1932x1932px, 45-degree field of view, fundus photo
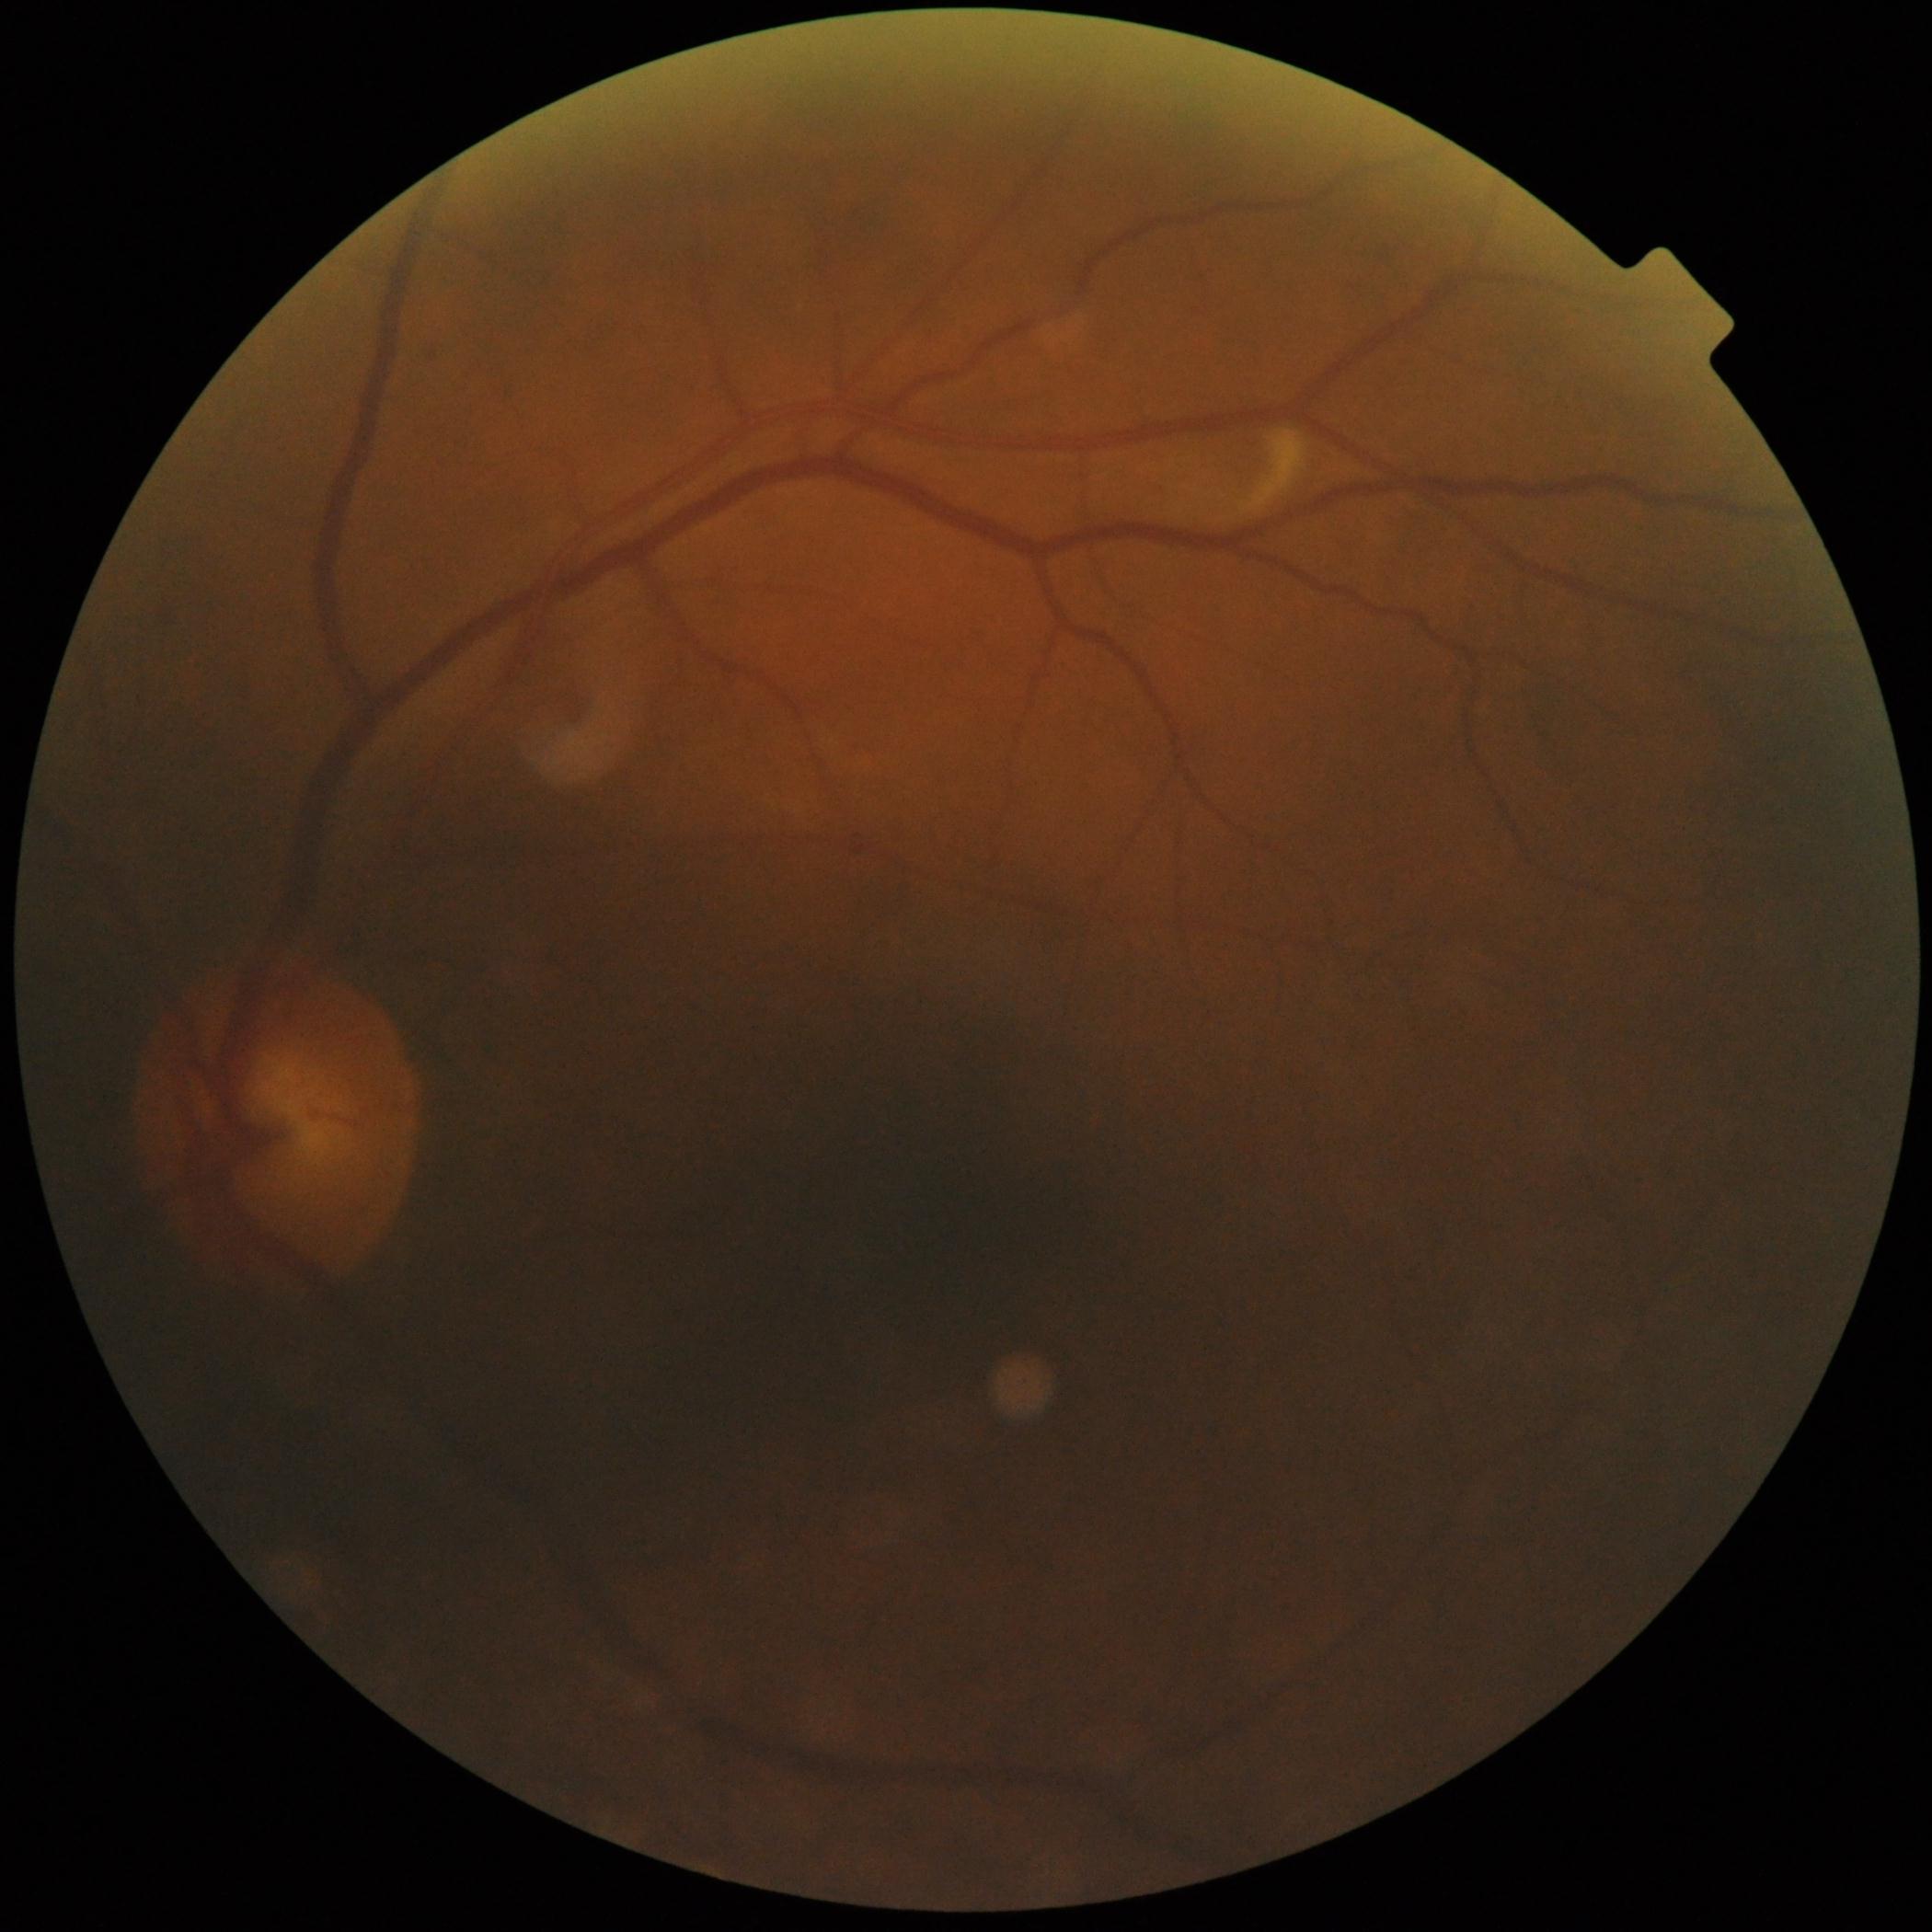
Diabetic retinopathy: 2 — more than just microaneurysms but less than severe NPDR. The retinopathy is classified as non-proliferative diabetic retinopathy.